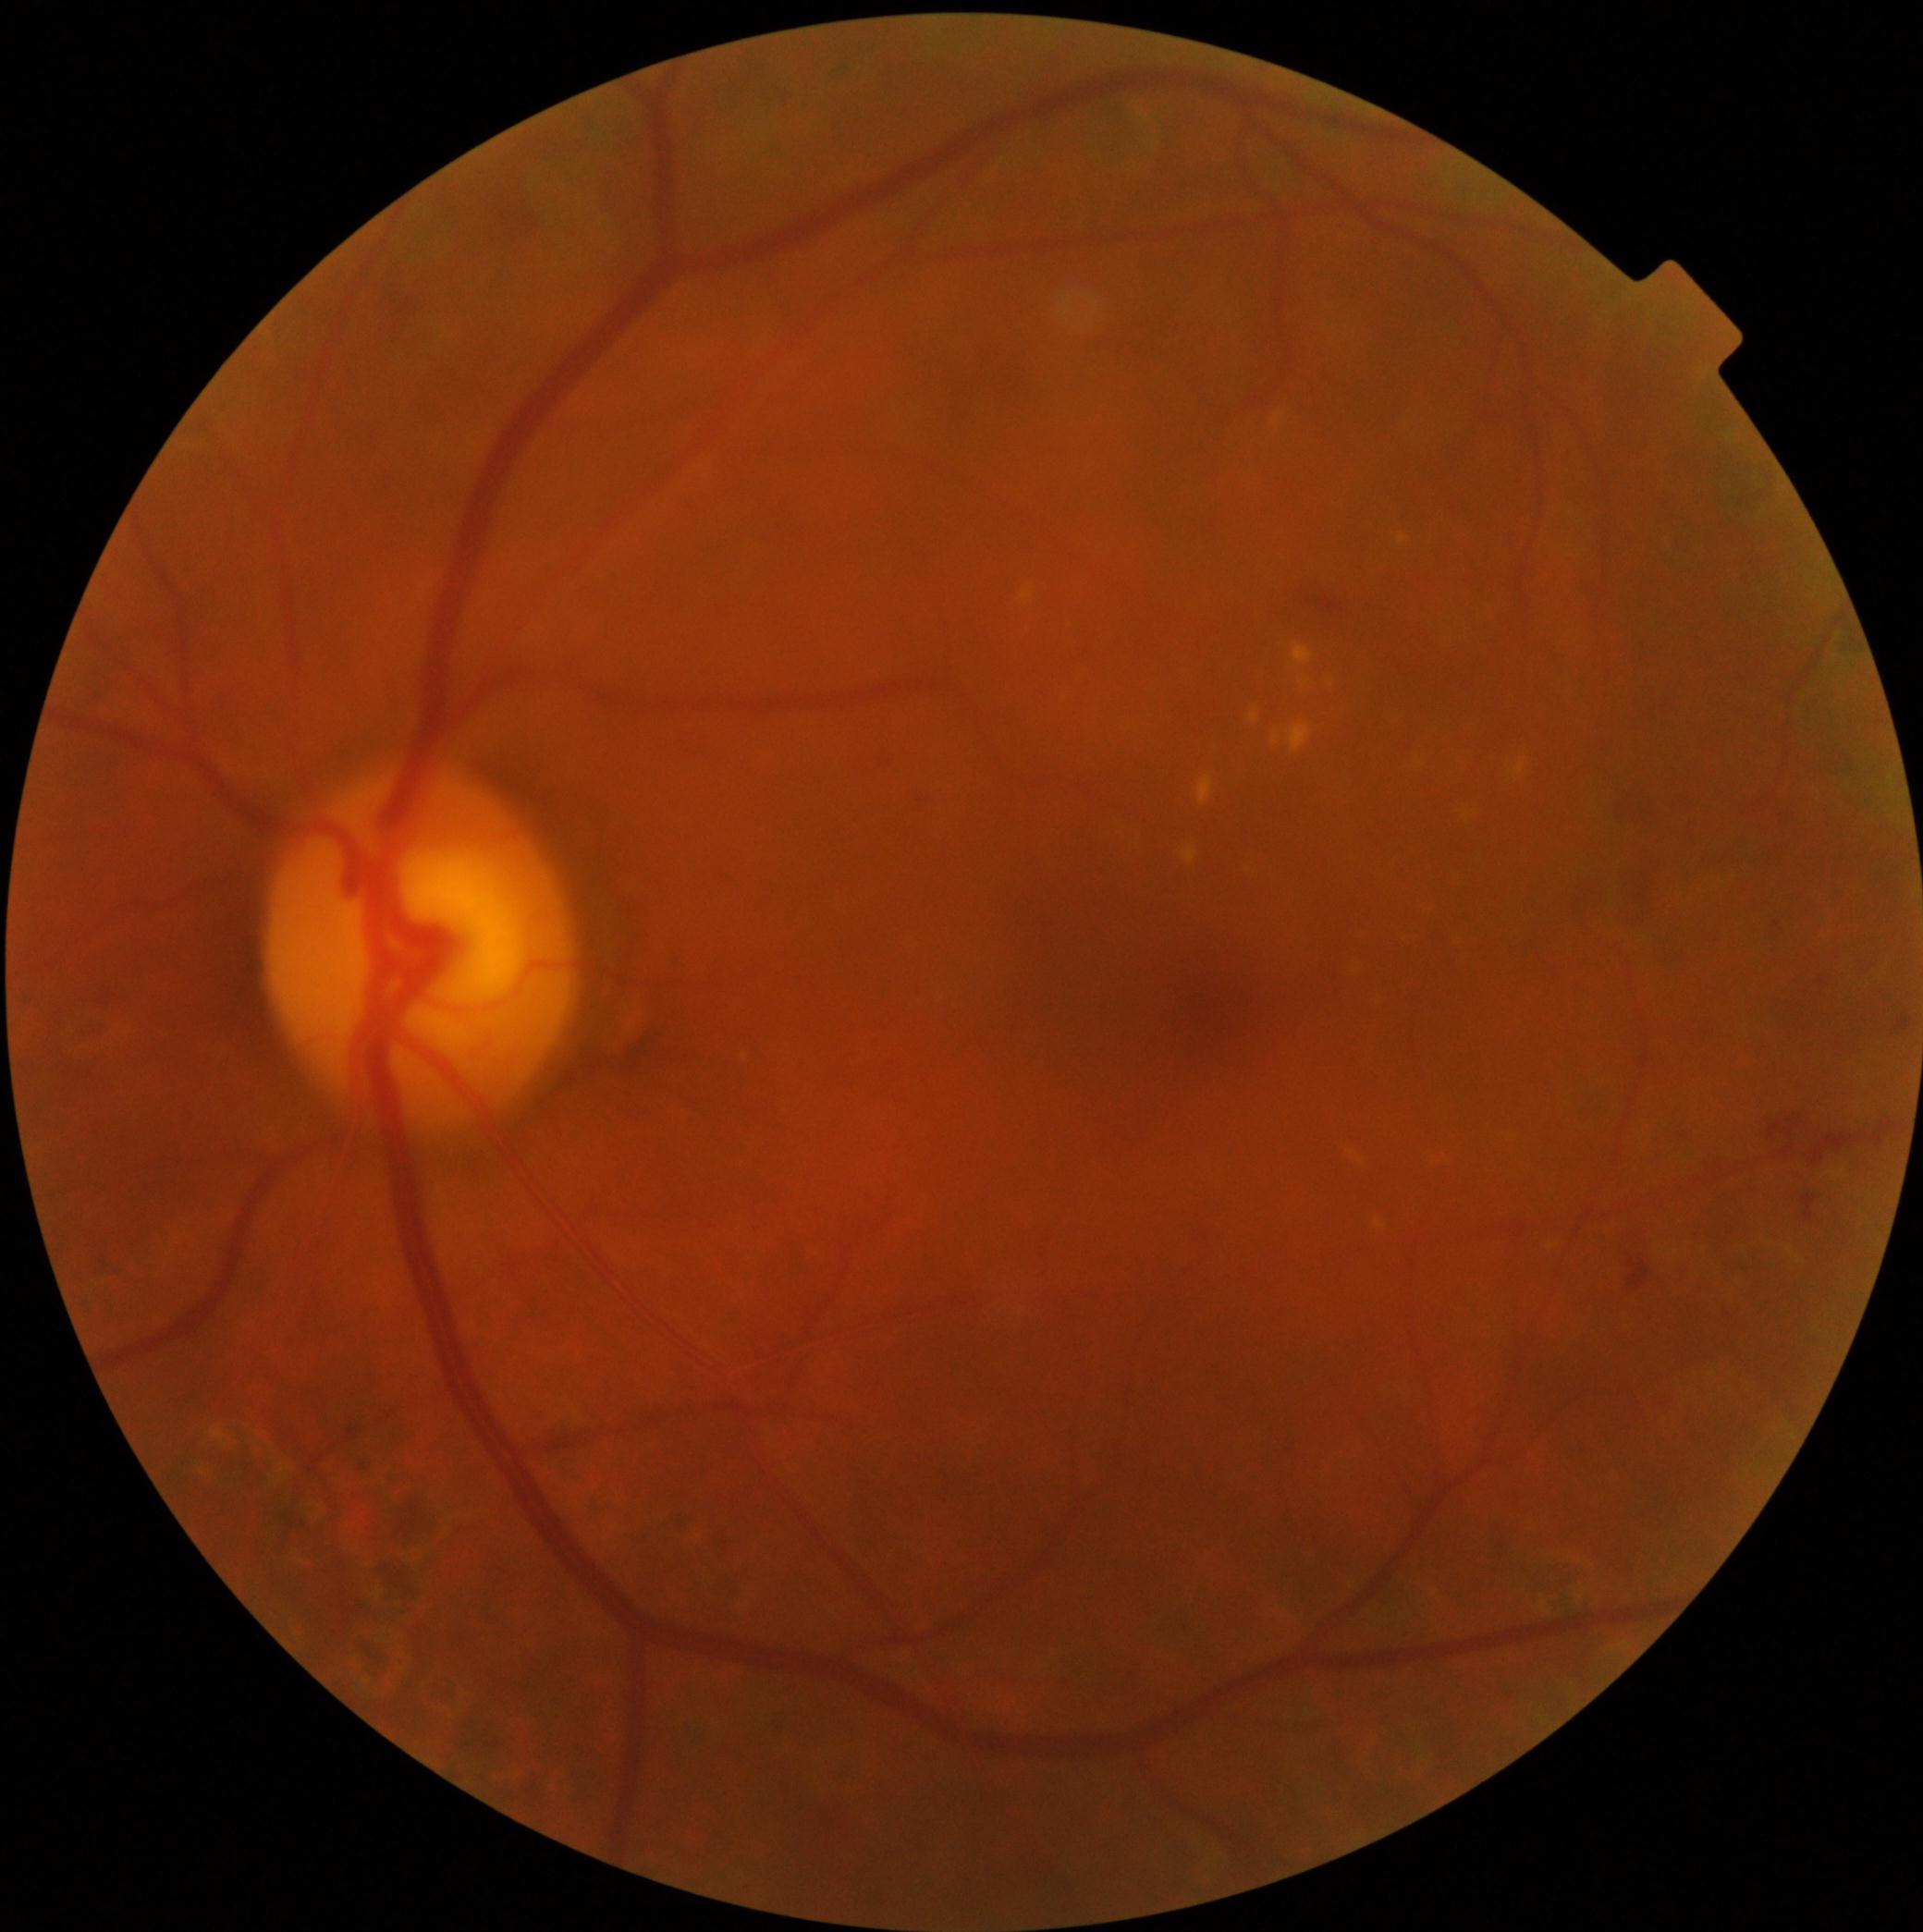

dr_category: non-proliferative diabetic retinopathy
dr_grade: 2